Wide-field fundus photograph of an infant:
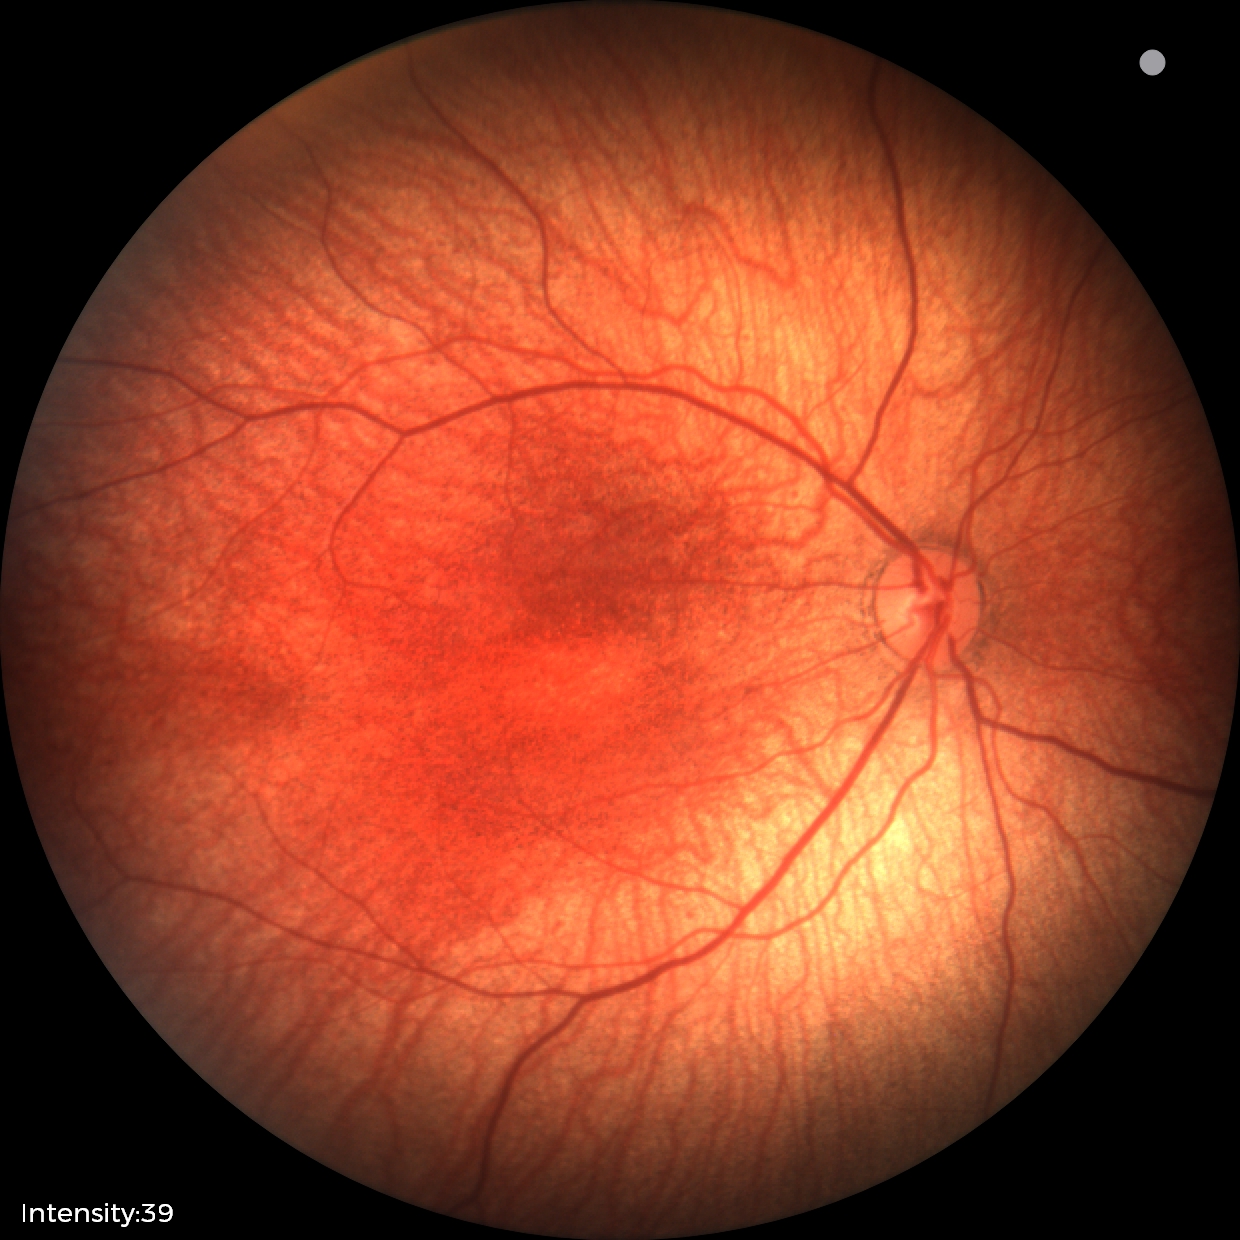 No retinal pathology identified on screening.